45° FOV. Without pupil dilation. 848x848px. Fundus photo
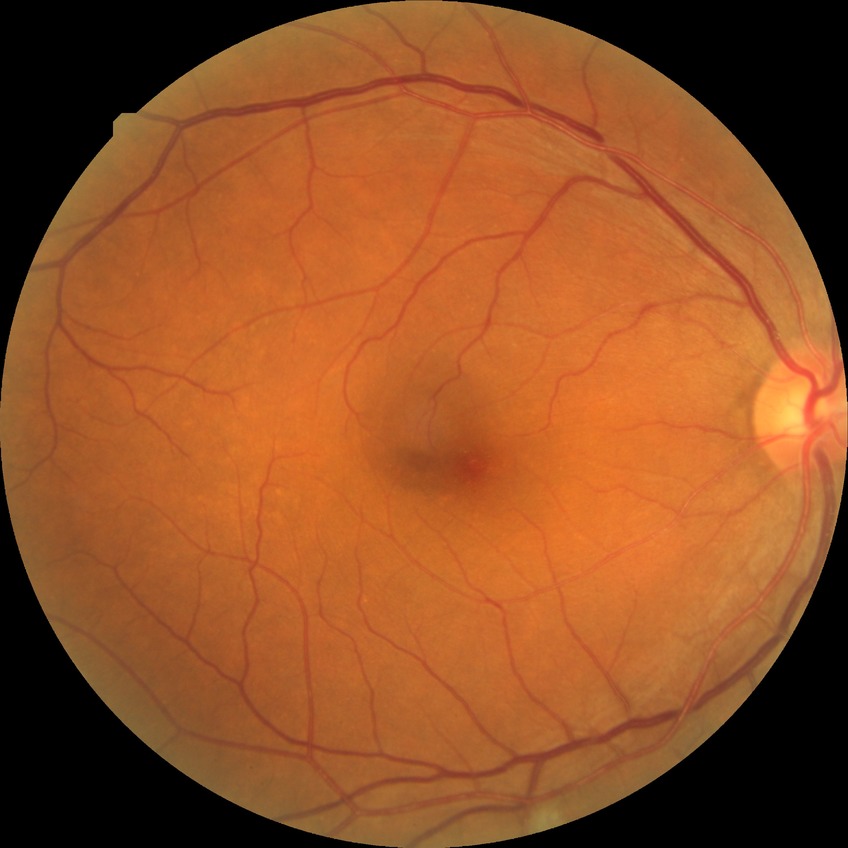
Davis grade = NDR.